RetCam wide-field infant fundus image · 640x480 · captured with the Clarity RetCam 3 (130° field of view)
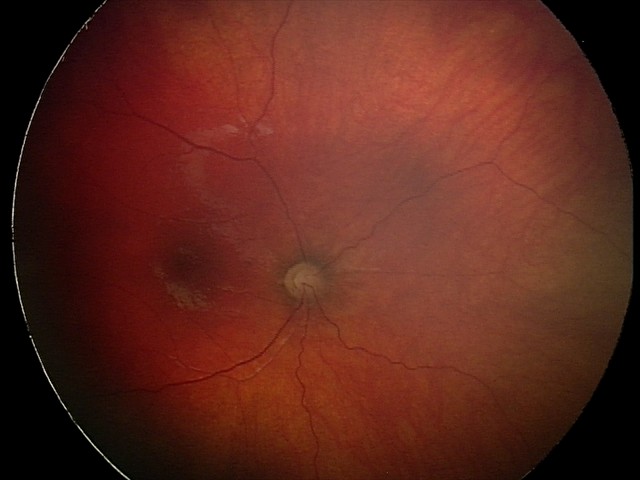
Series diagnosed as optic nerve hypoplasia.